Color fundus image. 45° field of view. 2048 by 1536 pixels
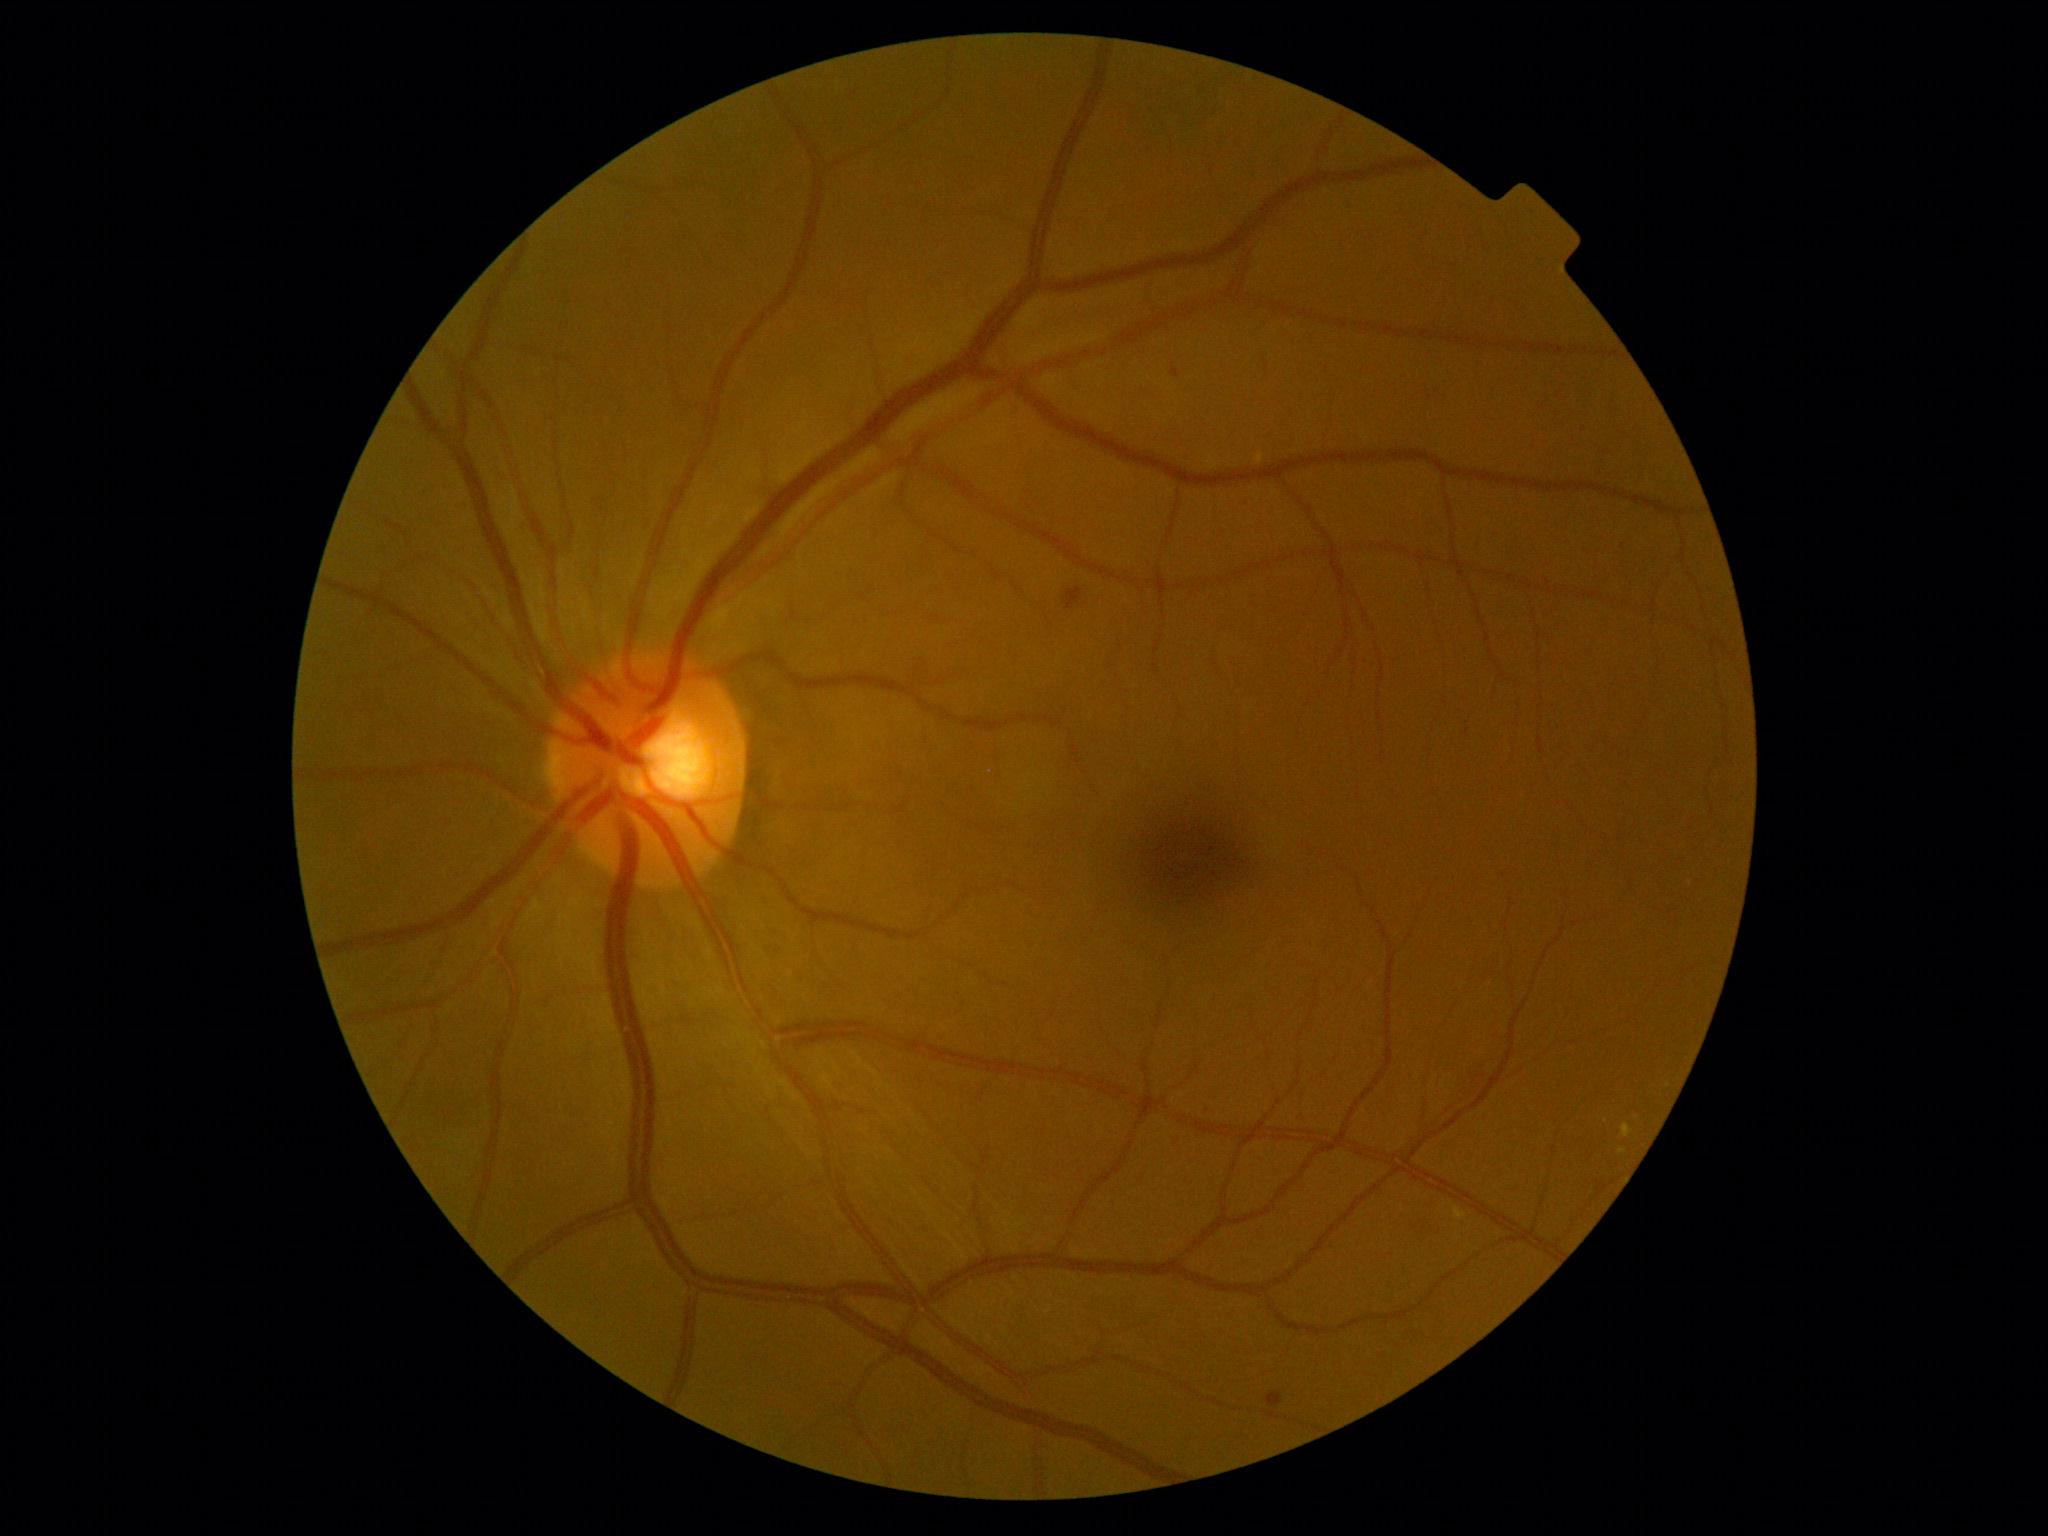

– diabetic retinopathy (DR): moderate non-proliferative diabetic retinopathy (grade 2) — more than just microaneurysms but less than severe NPDR
– DR class: non-proliferative diabetic retinopathy